45° FOV. Image size 848x848.
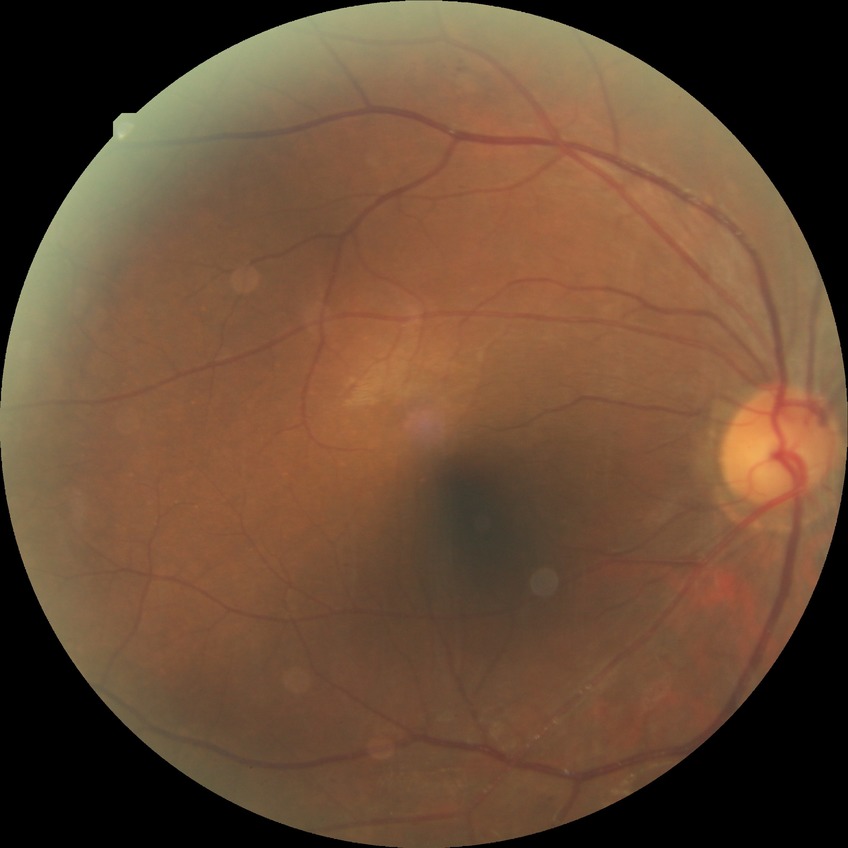
Retinopathy grade is pre-proliferative diabetic retinopathy.